Fundus photo; 2352 x 1568 pixels.
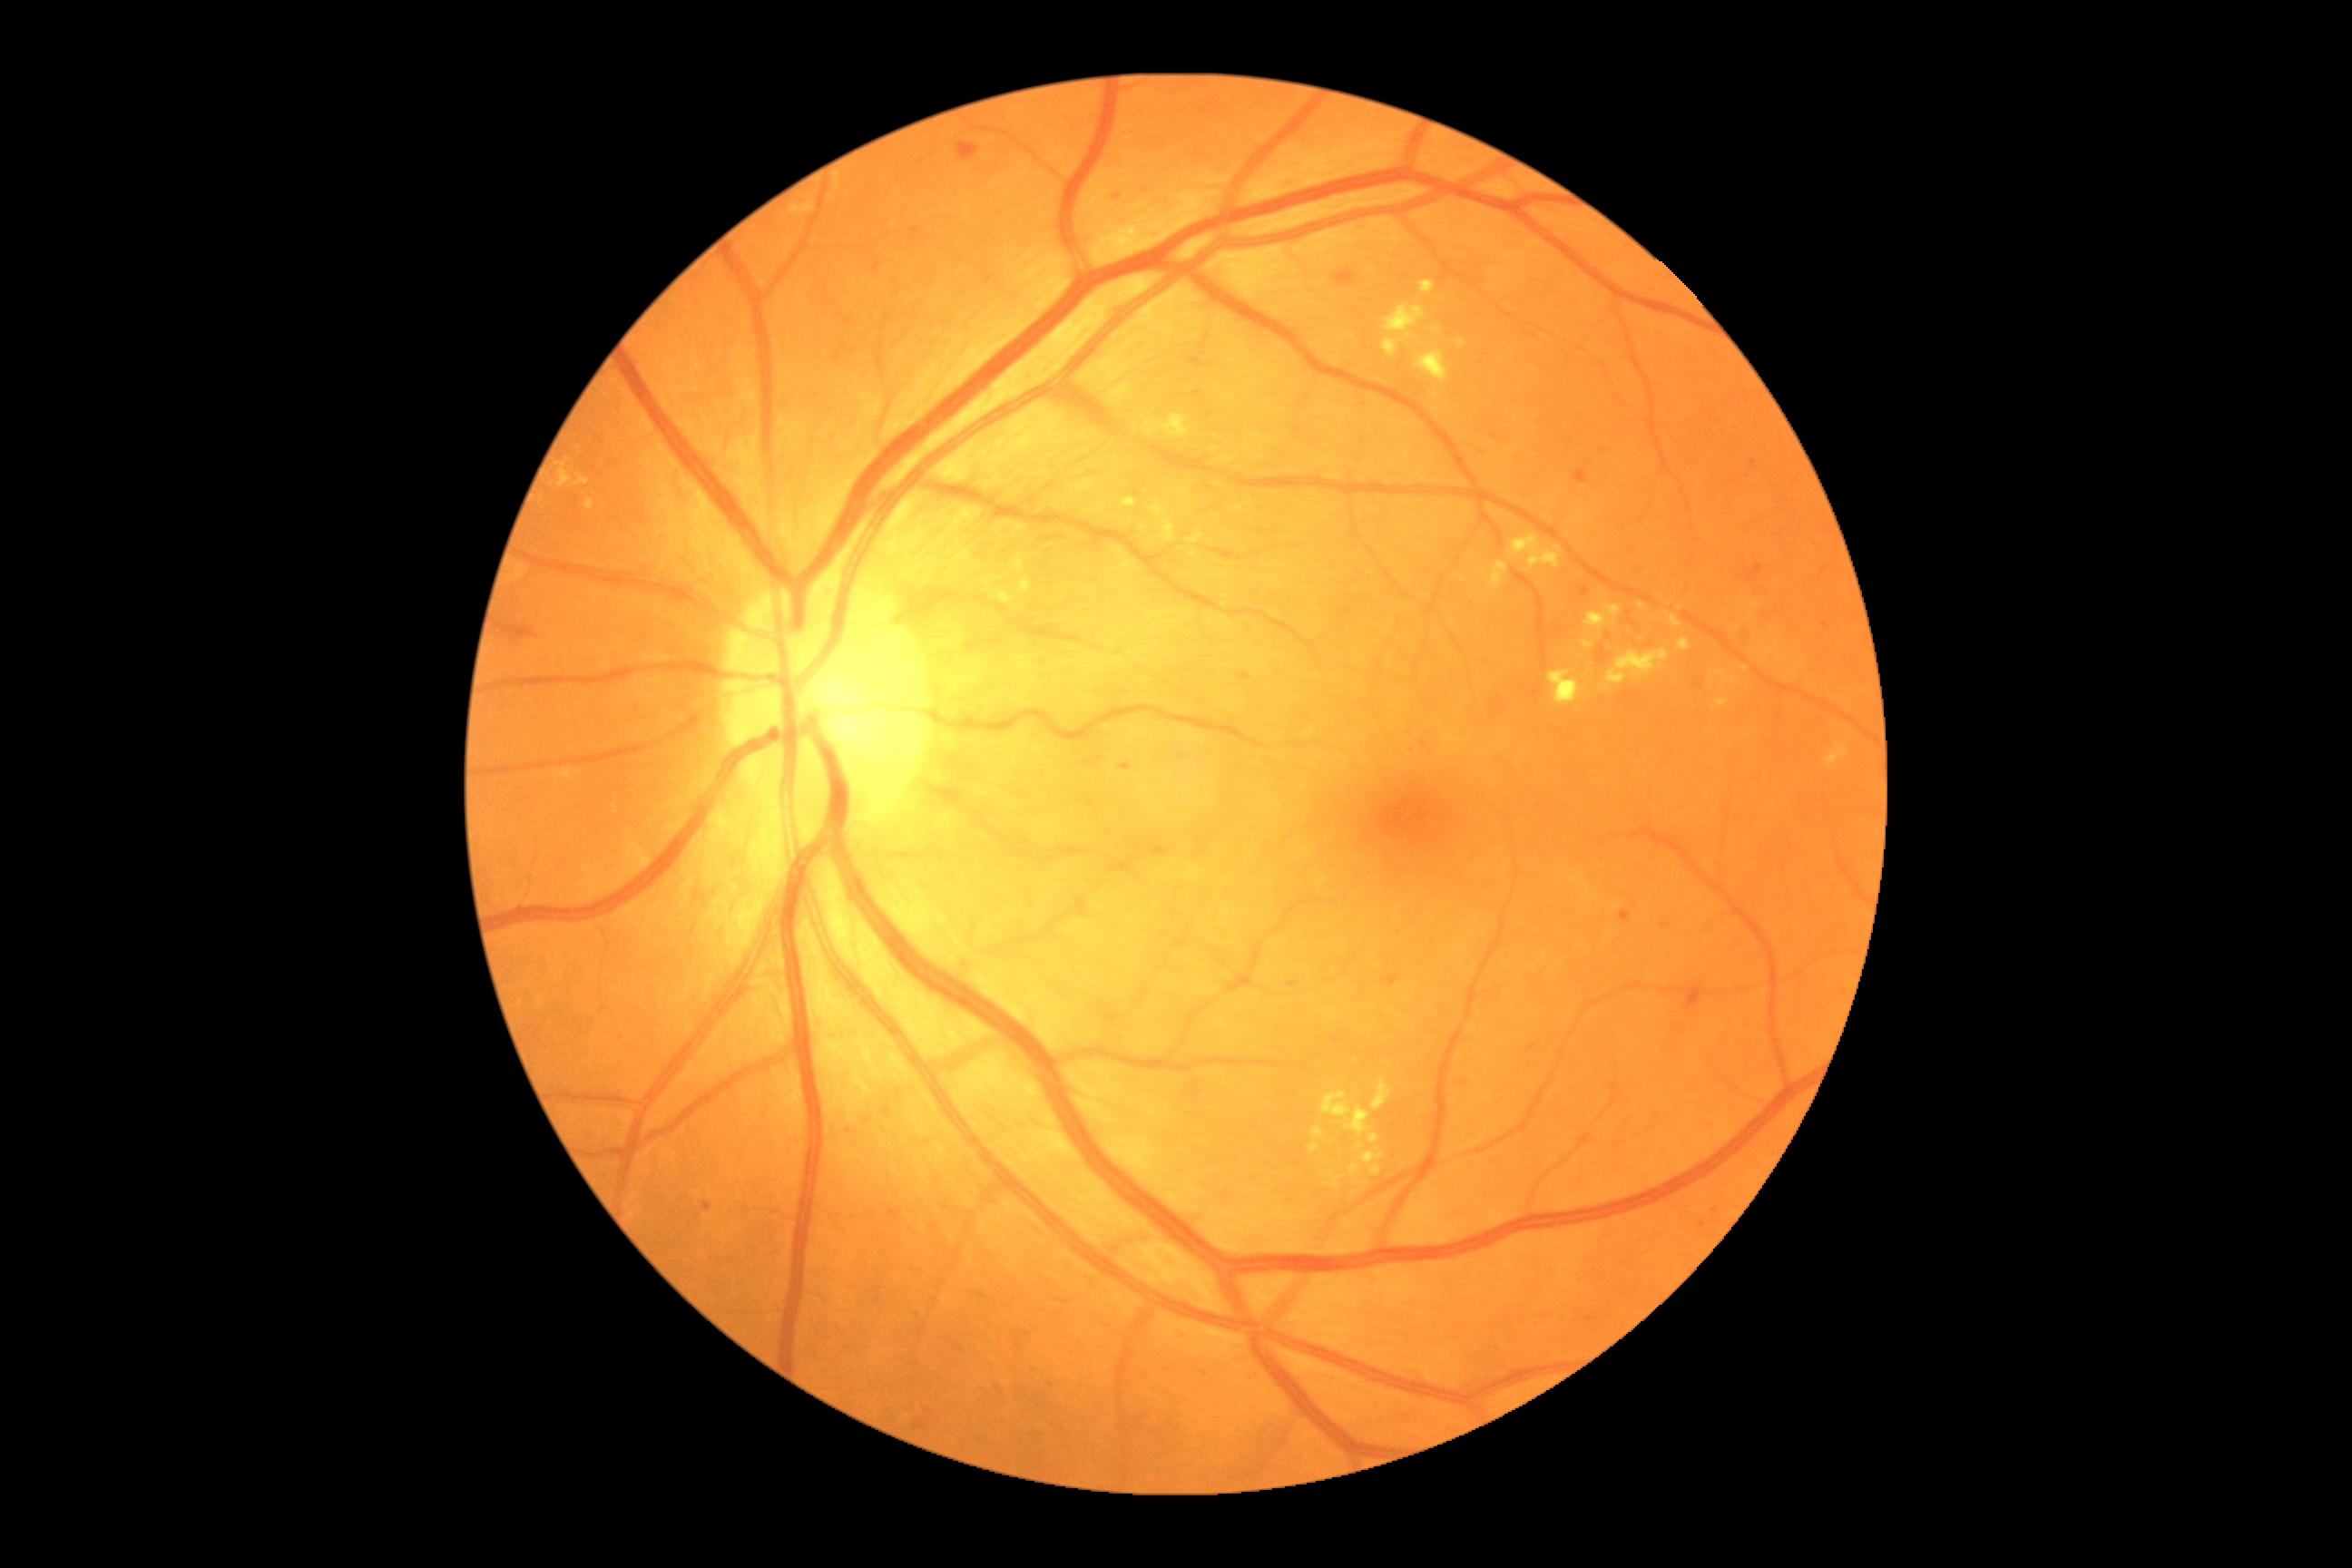

<lesions partial="true">
  <dr_grade>2</dr_grade>
  <ma partial="true">bbox=[1491, 433, 1500, 440]; bbox=[703, 1202, 712, 1213]; bbox=[1529, 1043, 1538, 1052]; bbox=[926, 1409, 934, 1415]; bbox=[1288, 981, 1298, 988]; bbox=[1712, 1210, 1720, 1215]; bbox=[1382, 975, 1400, 988]; bbox=[1605, 1081, 1616, 1092]; bbox=[1237, 672, 1253, 683]</ma>
  <ma_small_centers><pt>1118,198</pt>; <pt>1204,1374</pt>; <pt>1632,551</pt></ma_small_centers>
  <ex partial="true">bbox=[1360, 1150, 1386, 1177]; bbox=[1605, 605, 1623, 618]; bbox=[1144, 416, 1190, 438]; bbox=[1638, 603, 1647, 611]; bbox=[1162, 520, 1177, 542]; bbox=[1331, 1177, 1340, 1190]; bbox=[1725, 678, 1740, 687]; bbox=[1678, 638, 1690, 652]; bbox=[1320, 1092, 1371, 1137]; bbox=[1585, 612, 1607, 631]; bbox=[1509, 534, 1563, 573]; bbox=[1313, 1126, 1324, 1141]; bbox=[585, 500, 594, 511]; bbox=[1219, 458, 1235, 464]</ex>
  <ex_small_centers><pt>1144,528</pt>; <pt>1746,669</pt>; <pt>1364,1184</pt></ex_small_centers>
  <se />
  <he>bbox=[1594, 645, 1612, 665]; bbox=[1627, 612, 1636, 625]; bbox=[1685, 995, 1698, 1012]; bbox=[1014, 1338, 1024, 1353]; bbox=[498, 623, 538, 640]; bbox=[1188, 357, 1204, 369]; bbox=[1743, 565, 1763, 583]; bbox=[1692, 678, 1703, 691]; bbox=[912, 1422, 930, 1431]; bbox=[1573, 469, 1589, 484]; bbox=[883, 1108, 890, 1117]; bbox=[1335, 270, 1357, 288]; bbox=[957, 142, 981, 161]</he>
  <he_small_centers><pt>1026,1335</pt></he_small_centers>
</lesions>